1600x1200px. 45° FOV. Color fundus photograph
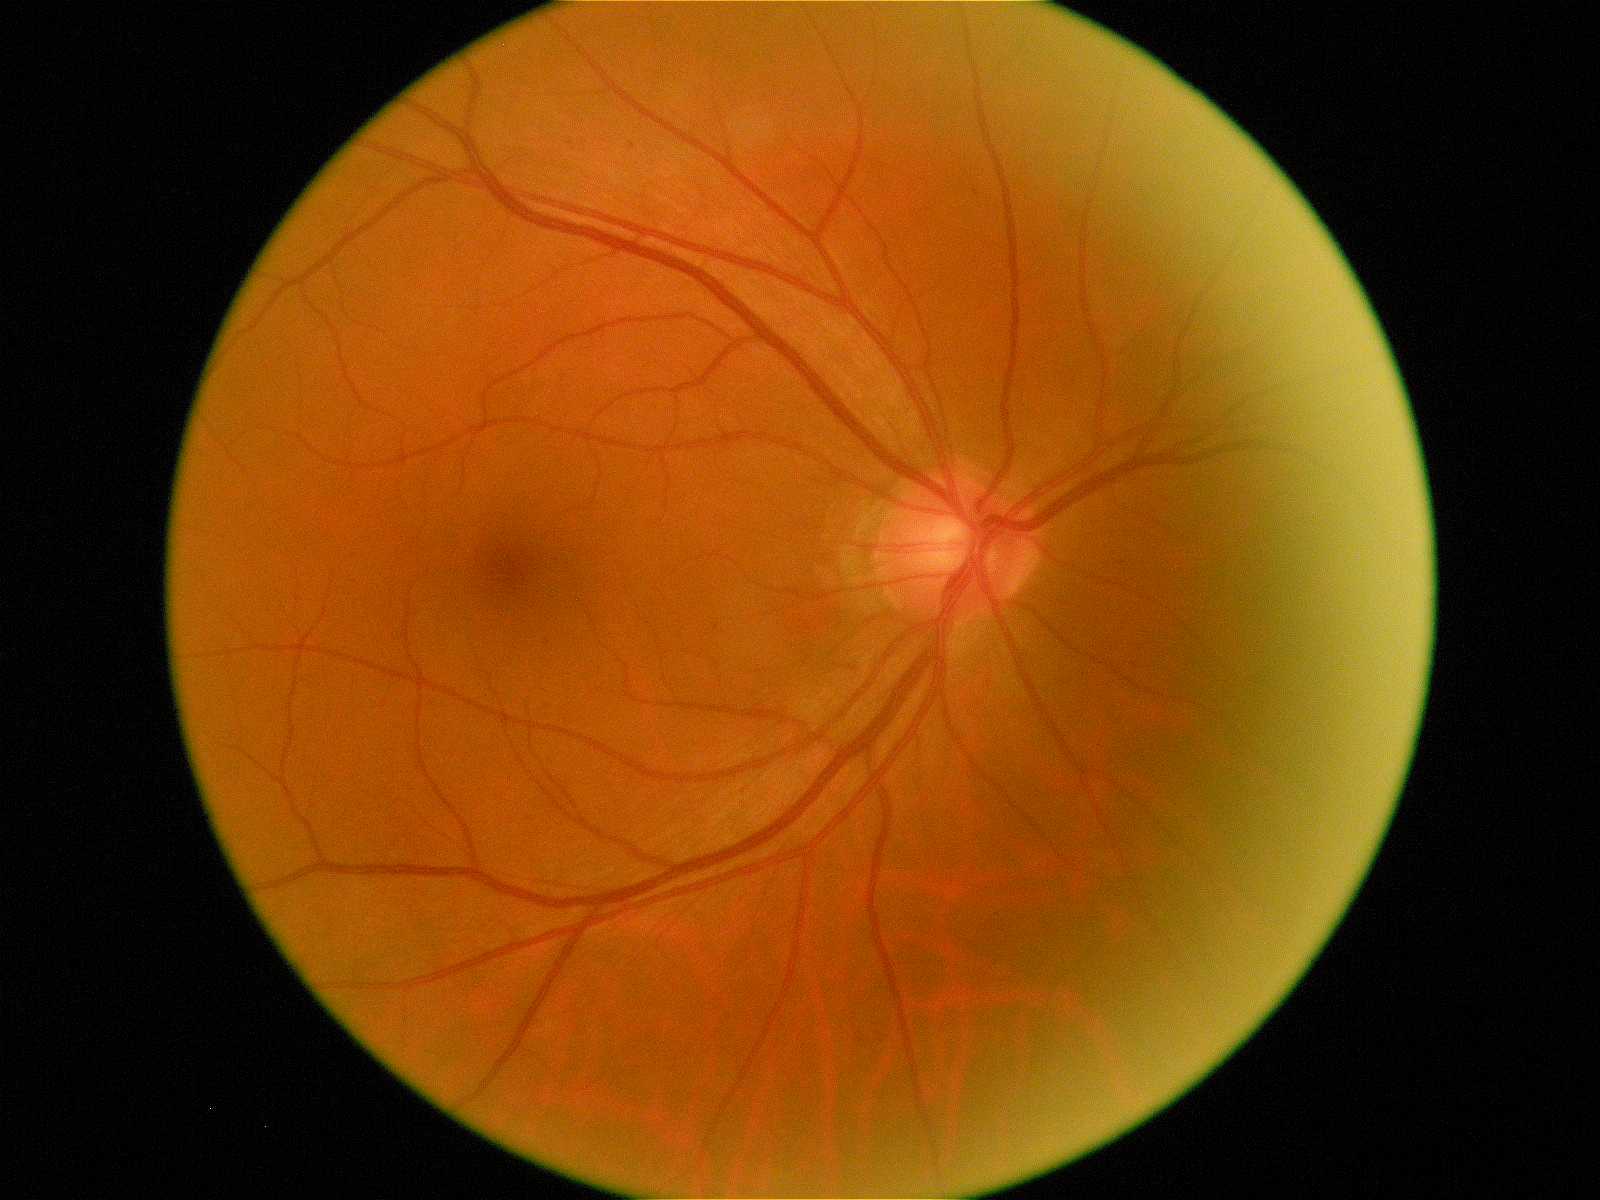

retinopathy grade: 1 (mild NPDR)